Camera: Clarity RetCam 3 (130° FOV). Wide-field contact fundus photograph of an infant:
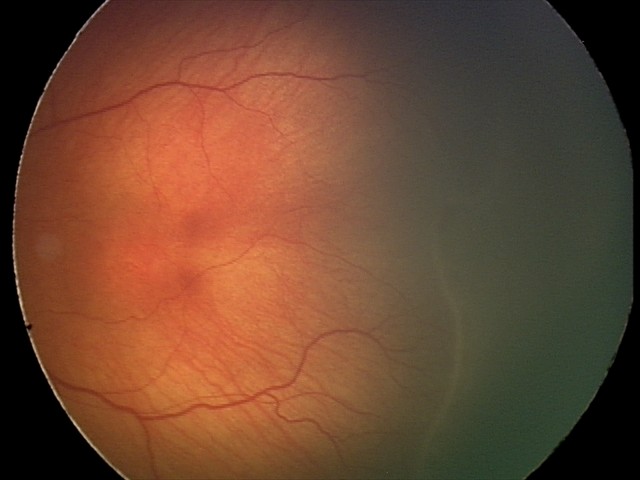
Without plus disease.
Diagnosis from this screening exam: ROP stage 2.